Color fundus image. 2352x1568px: 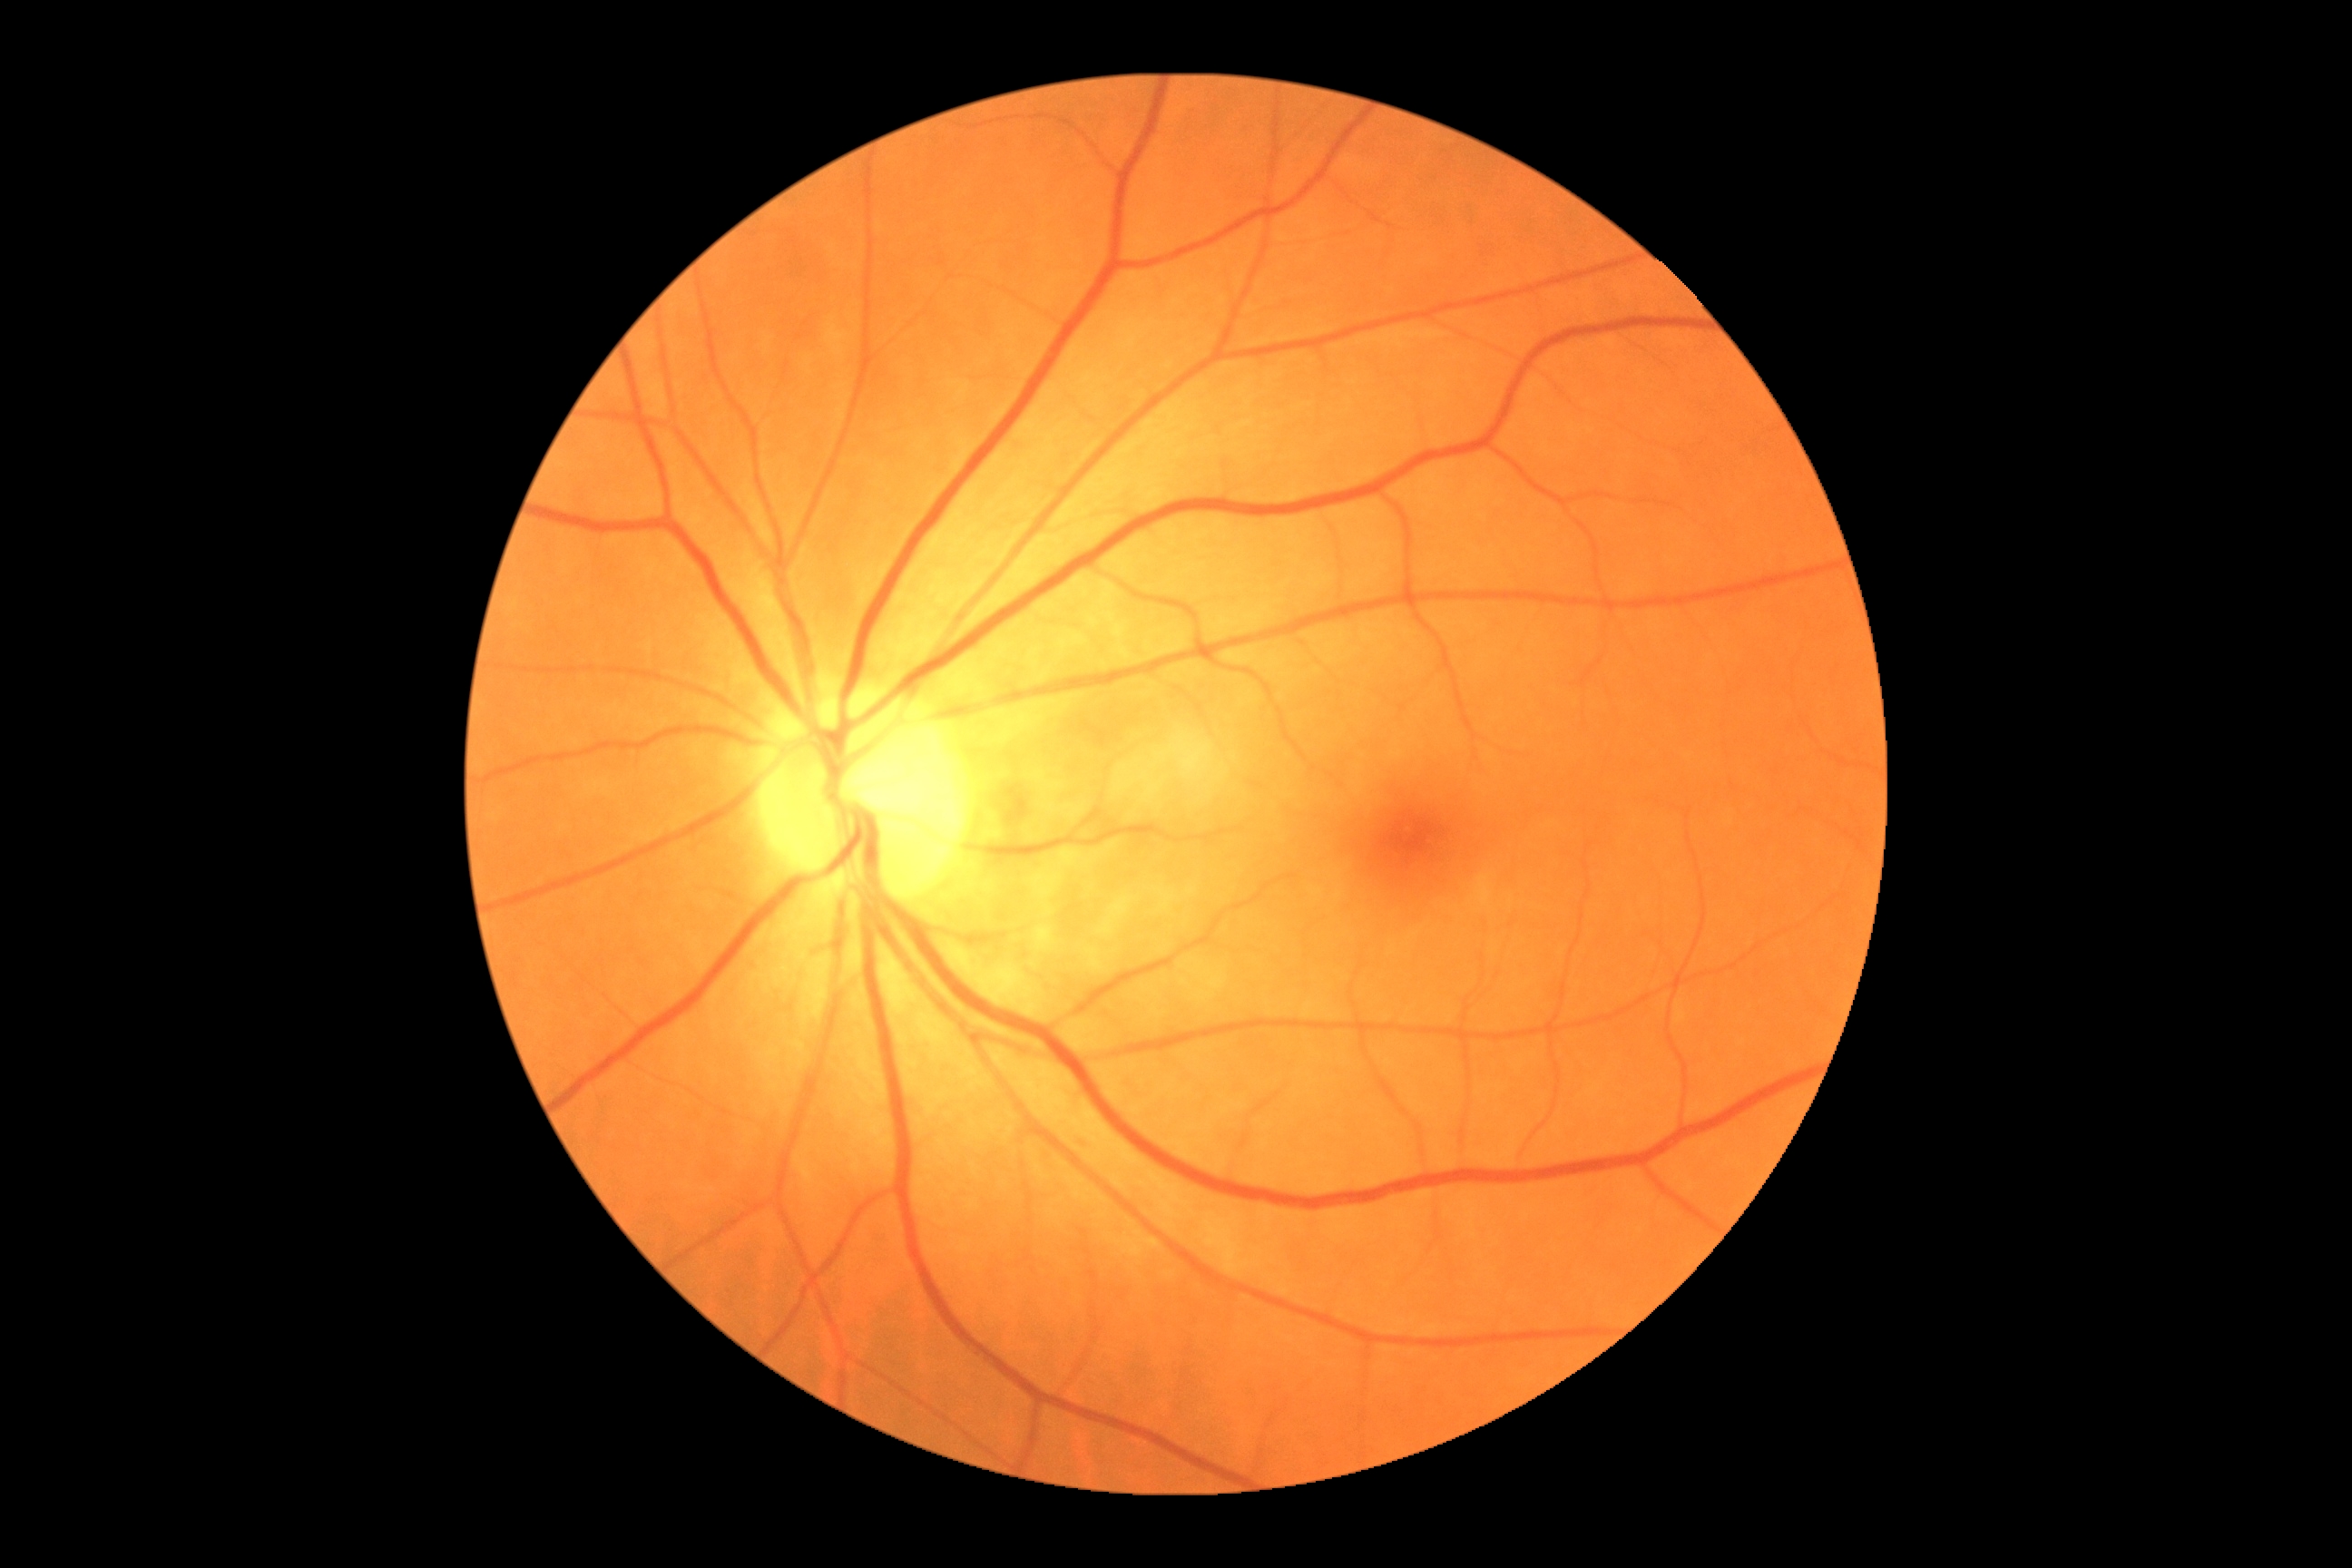
Diabetic retinopathy grade is 0 (no apparent retinopathy).